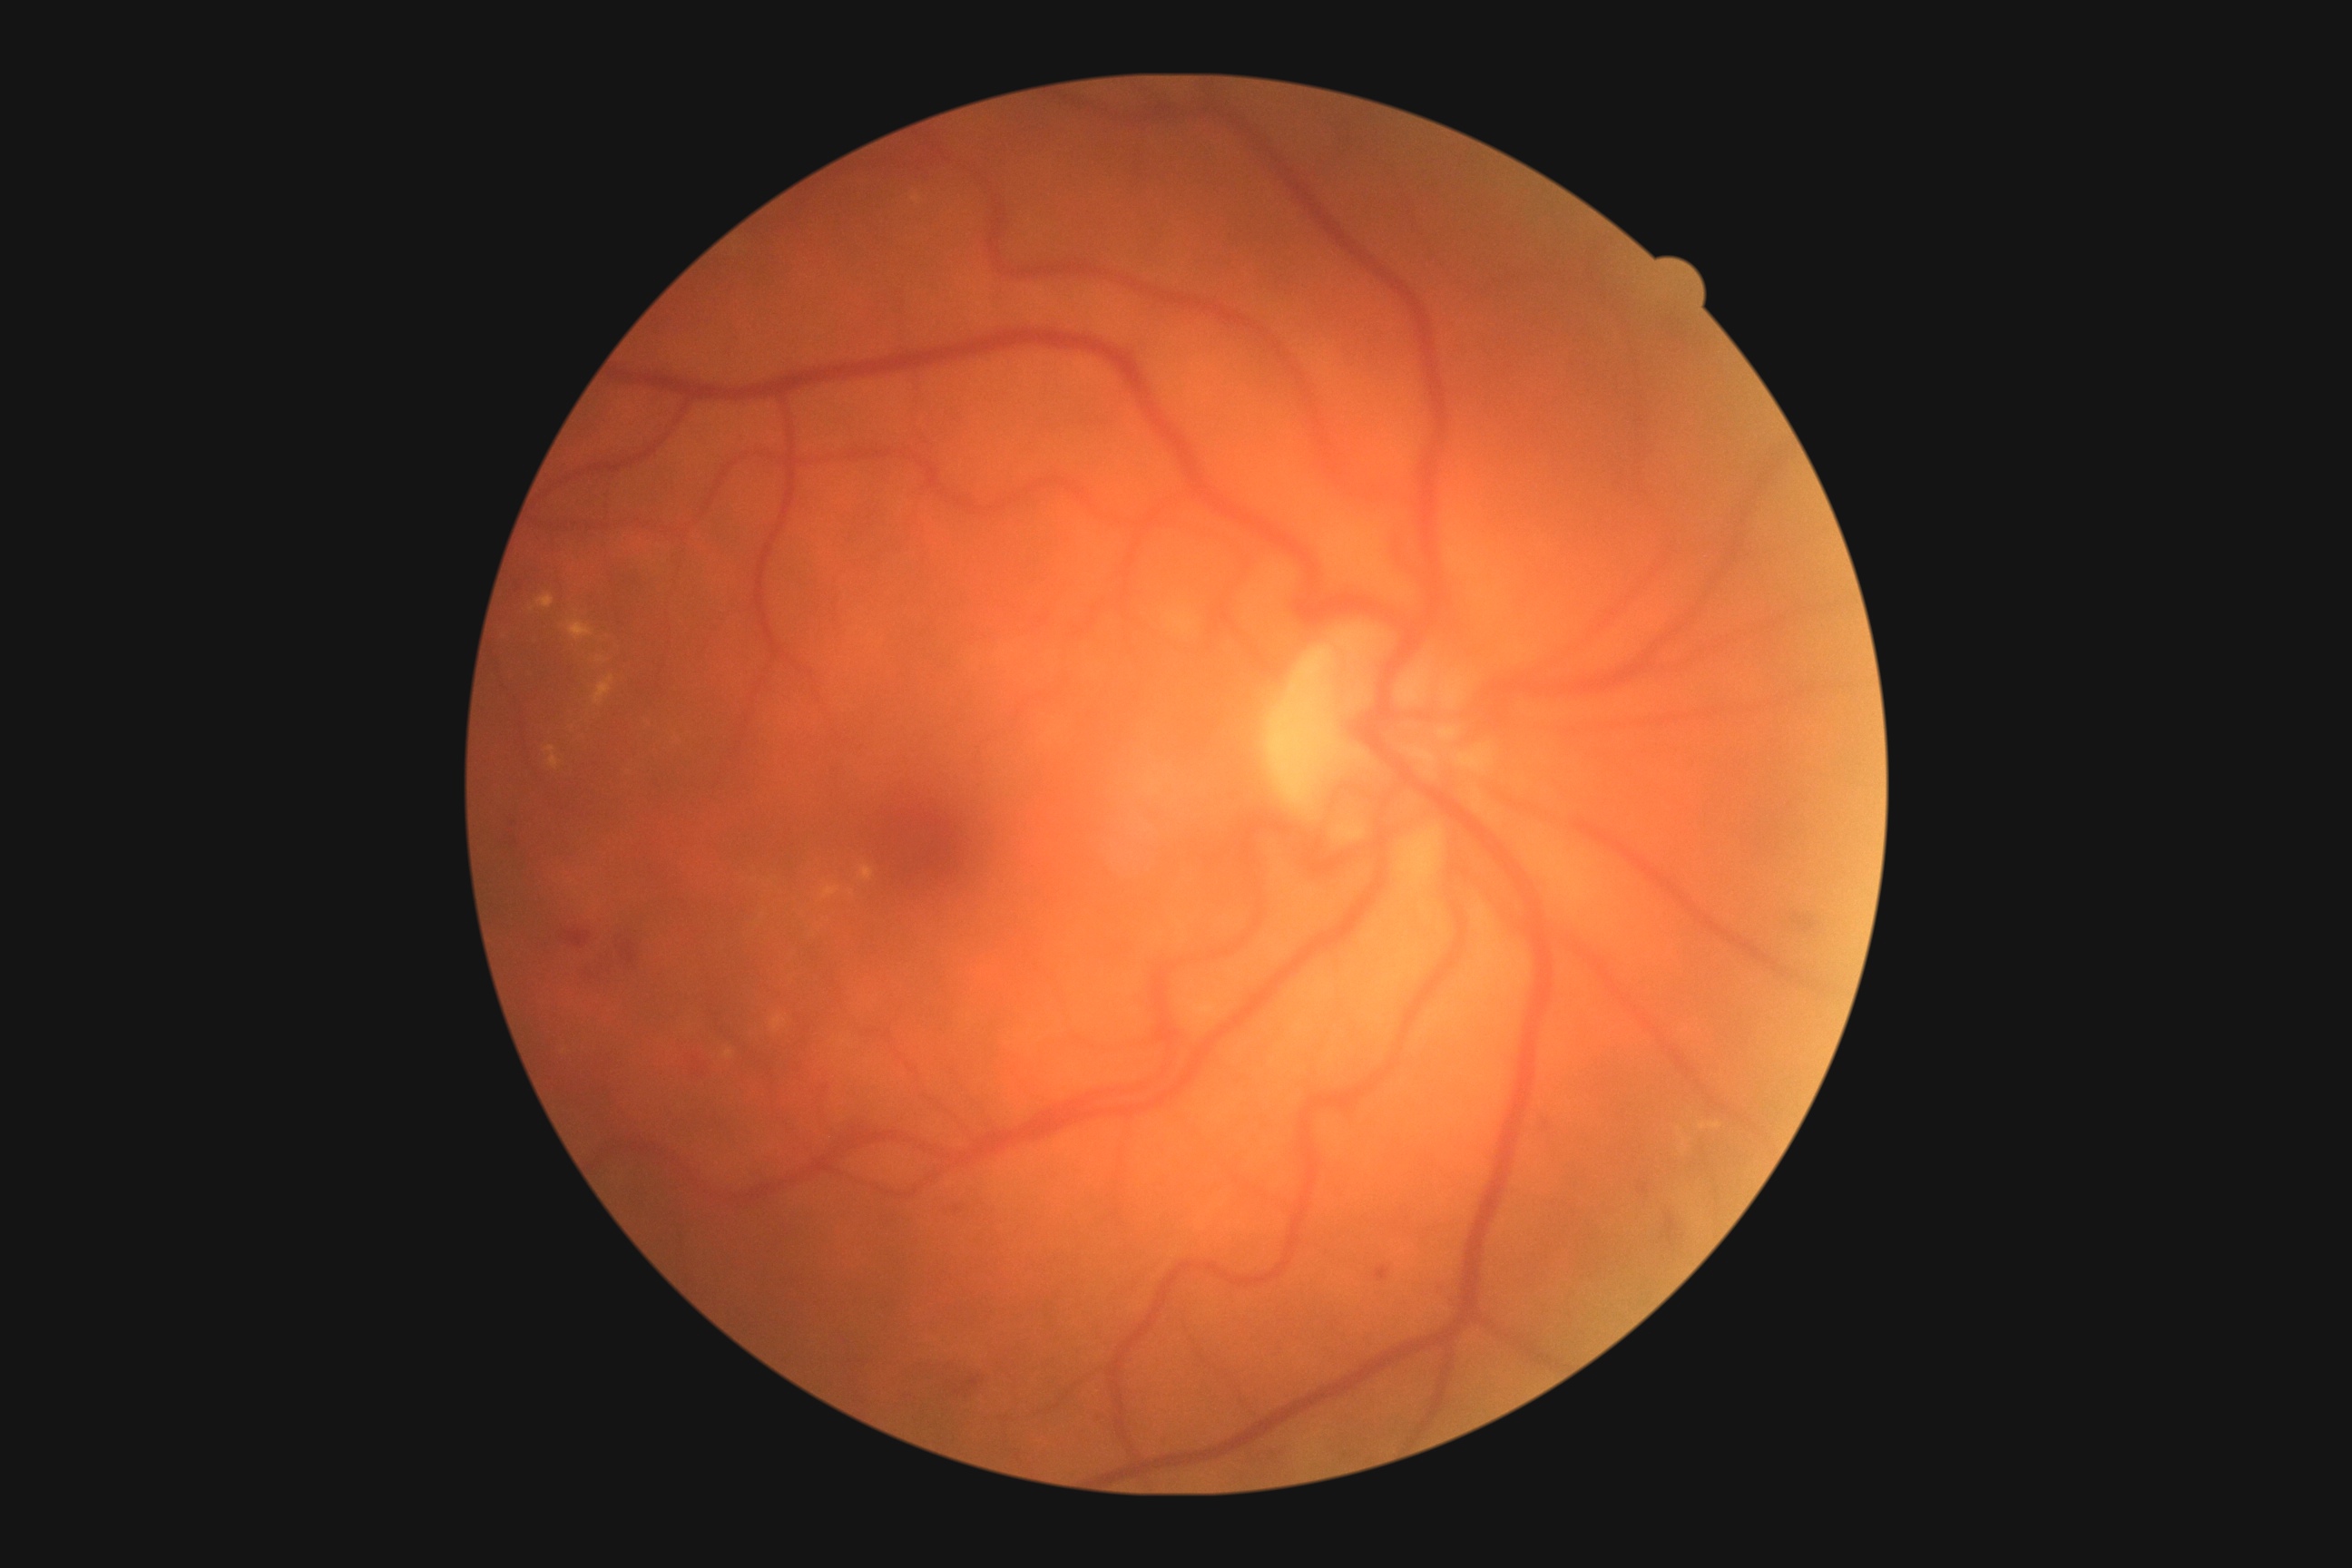 Retinopathy is moderate non-proliferative diabetic retinopathy (grade 2).